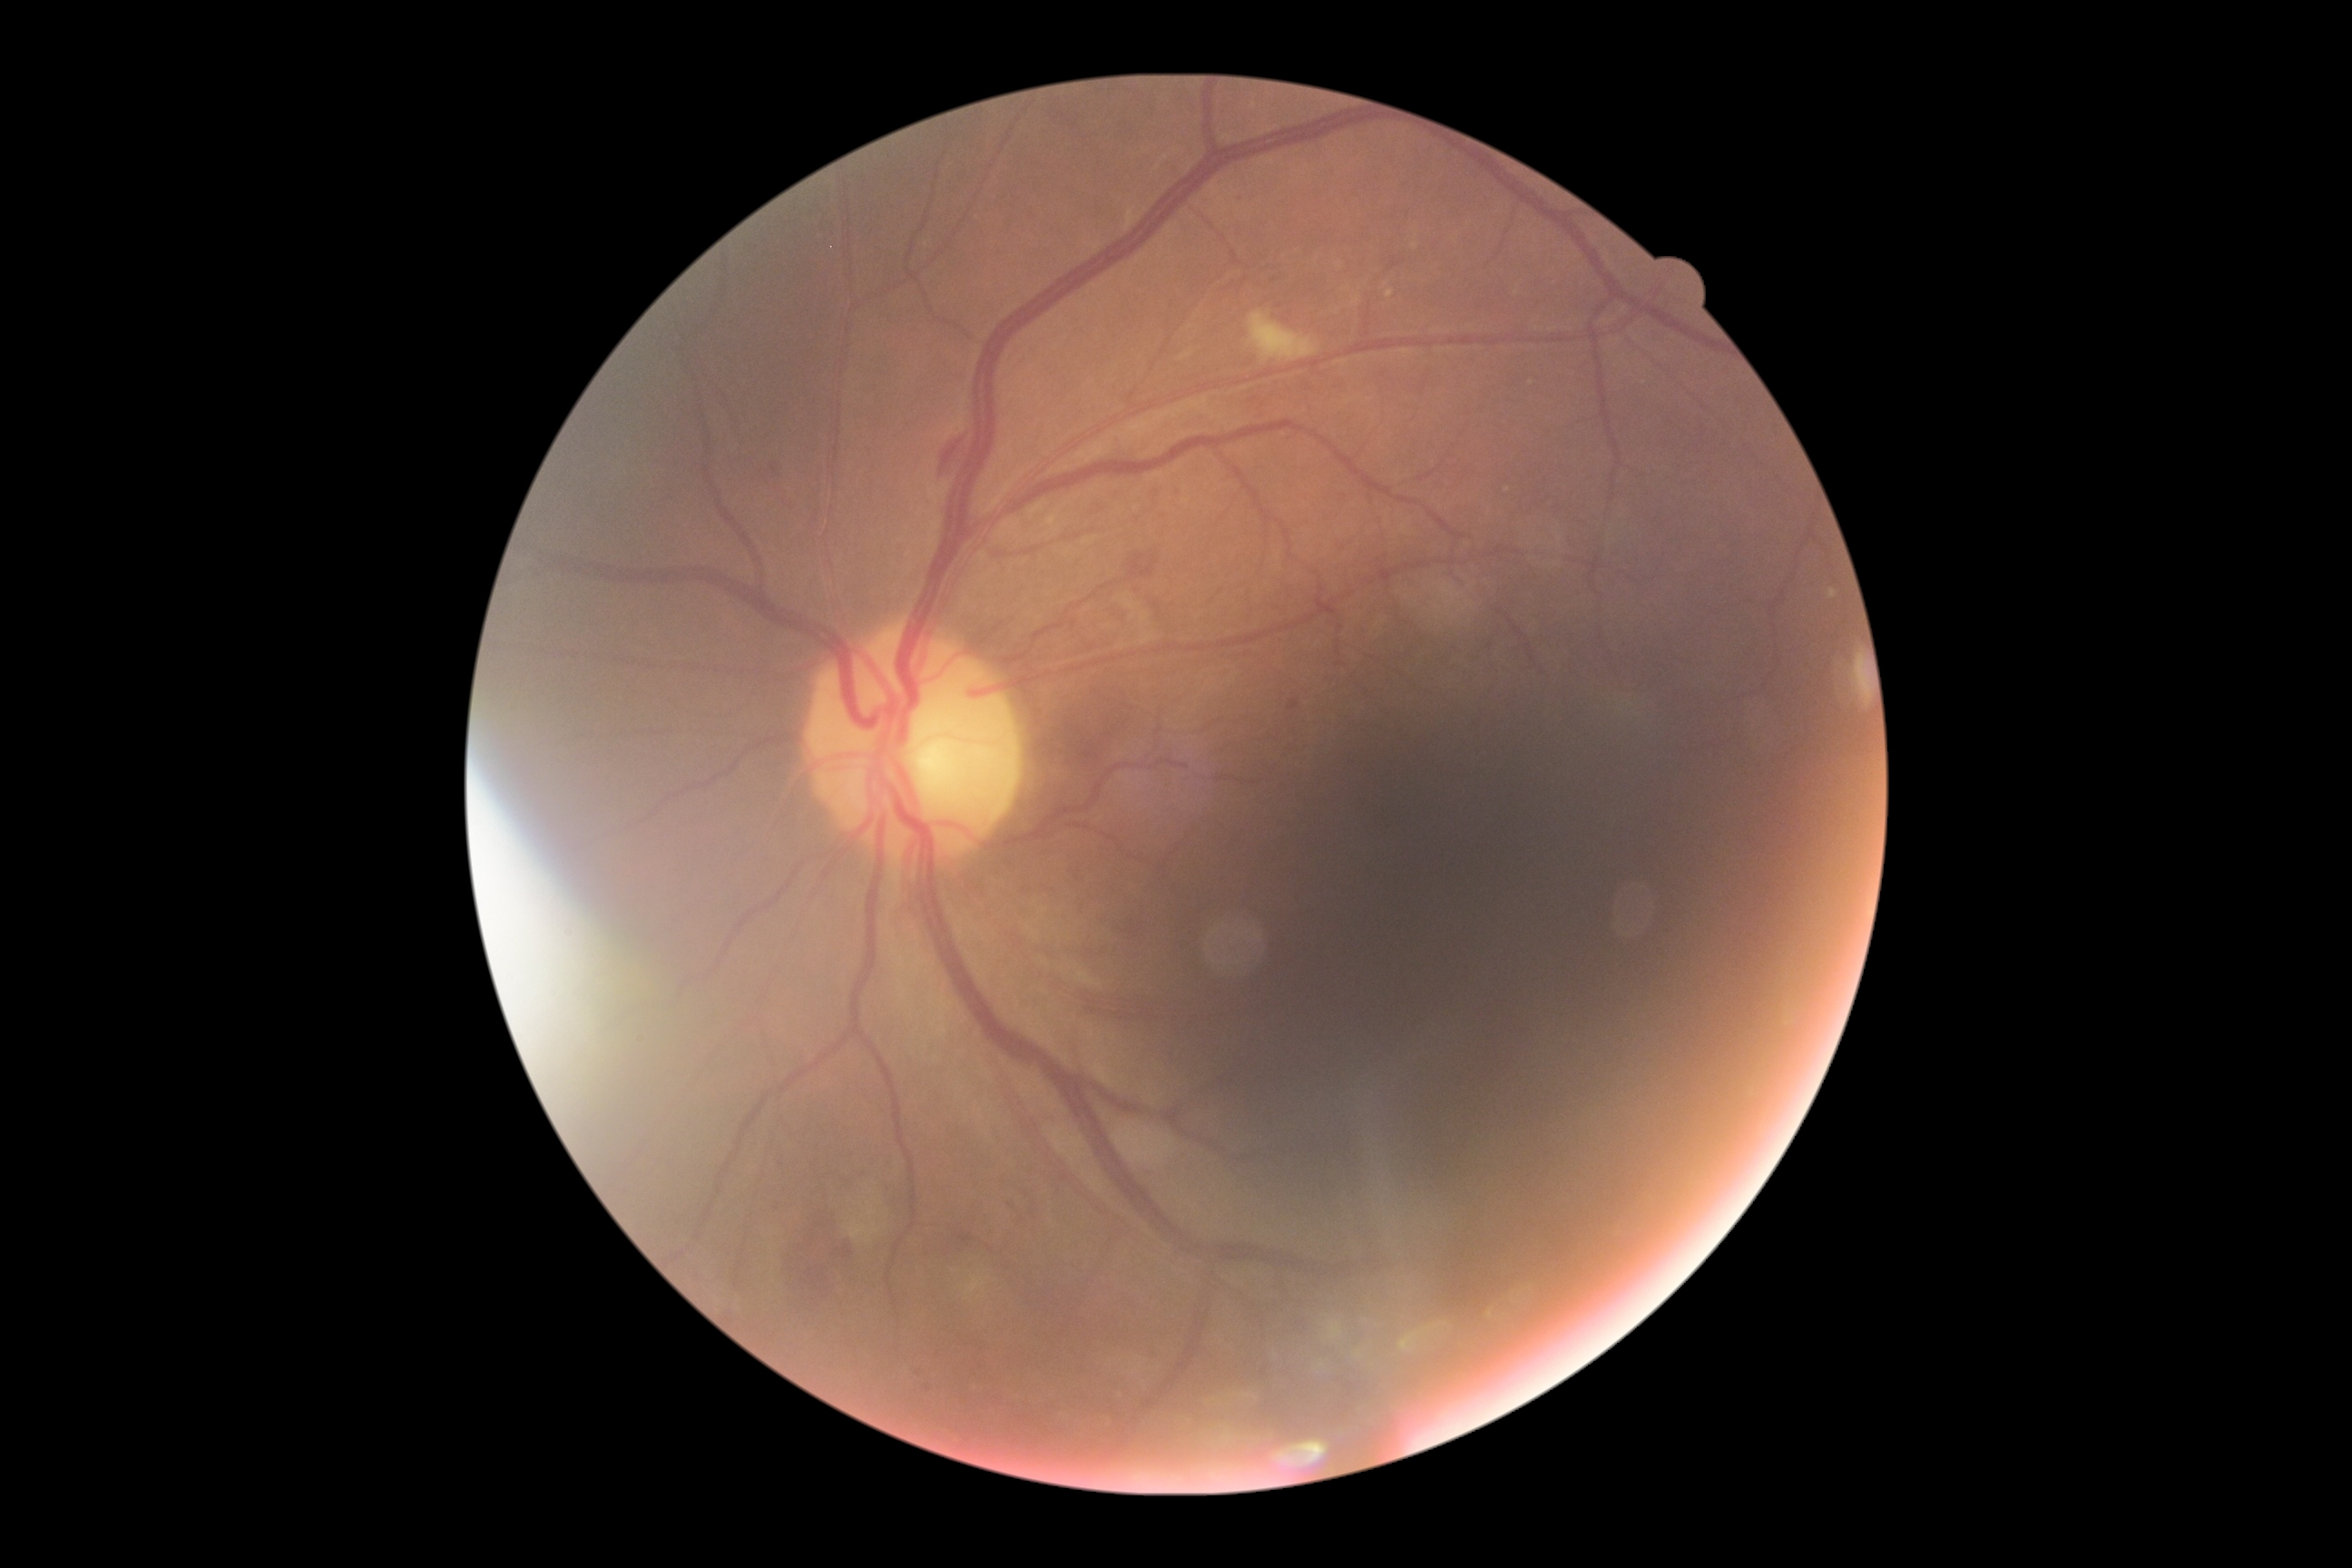

Diabetic retinopathy grade: moderate NPDR (2).